45° field of view; image size 1932x1916
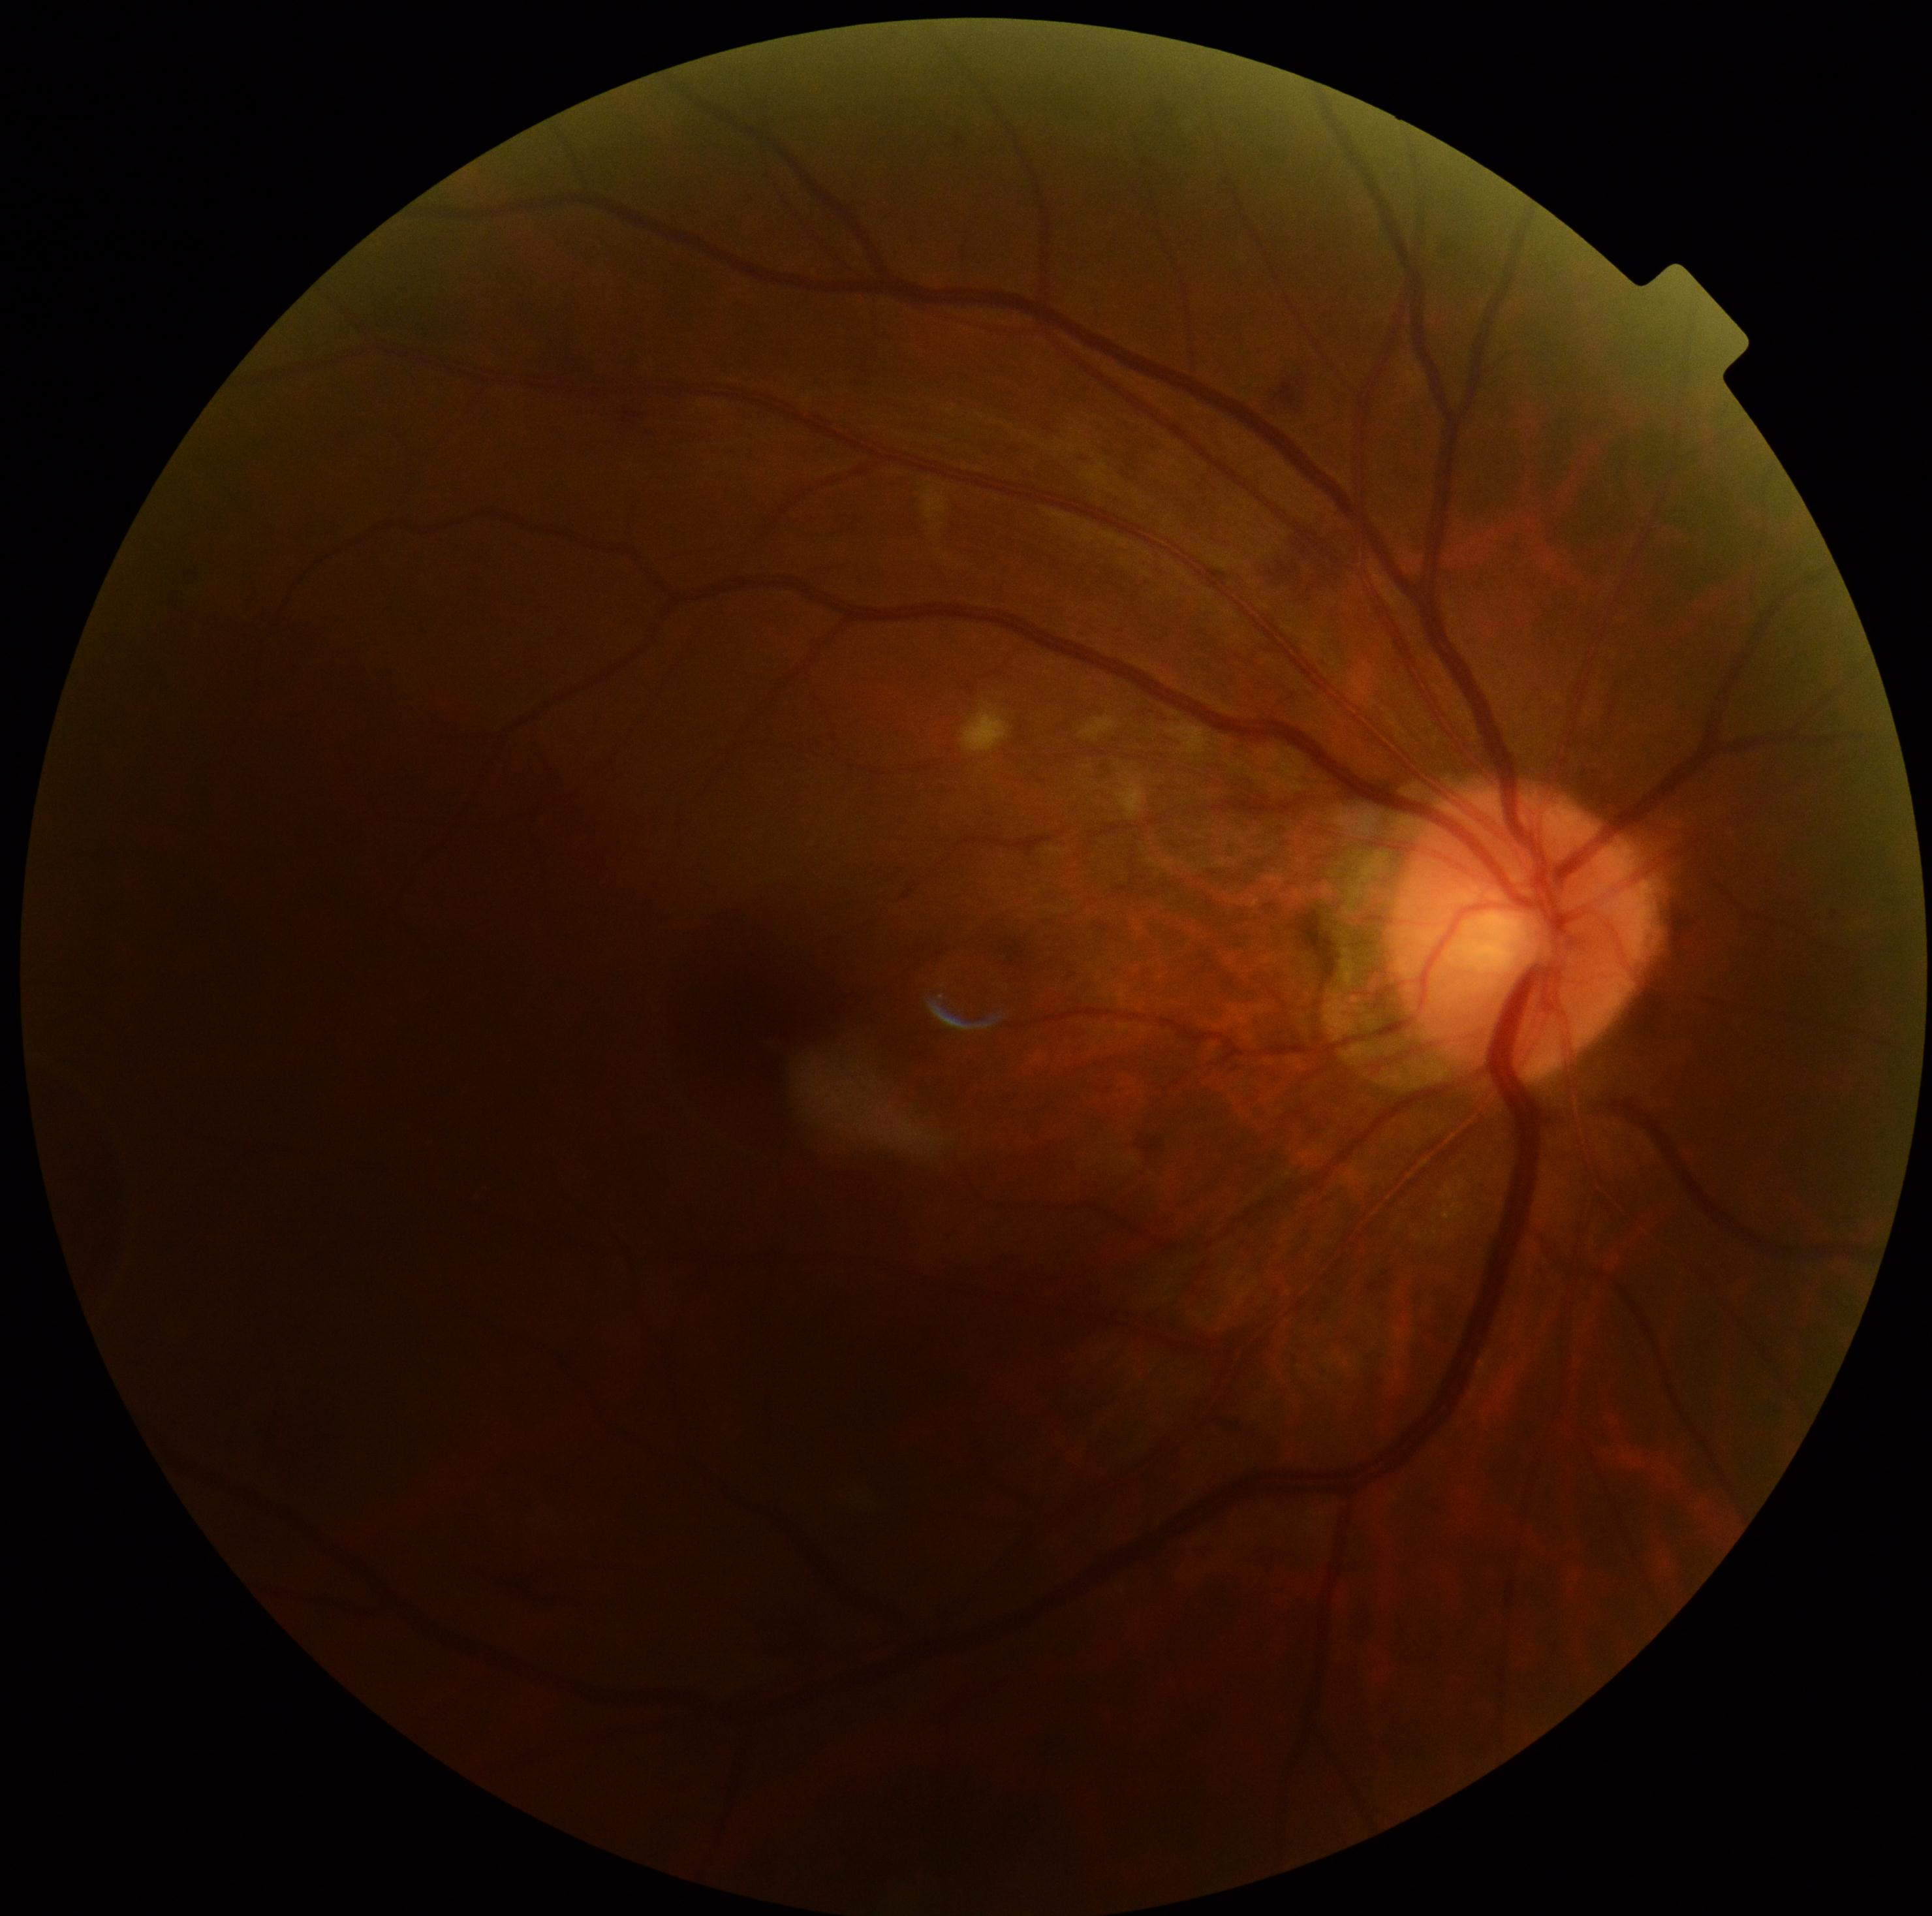 Diabetic retinopathy (DR): moderate NPDR (grade 2) — more than just microaneurysms but less than severe NPDR.